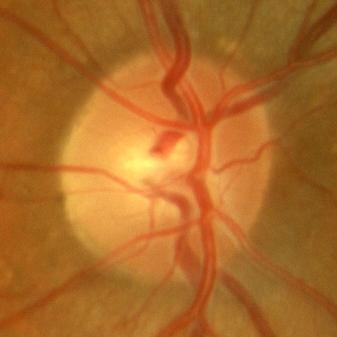
Finding: no glaucomatous damage.